45° field of view:
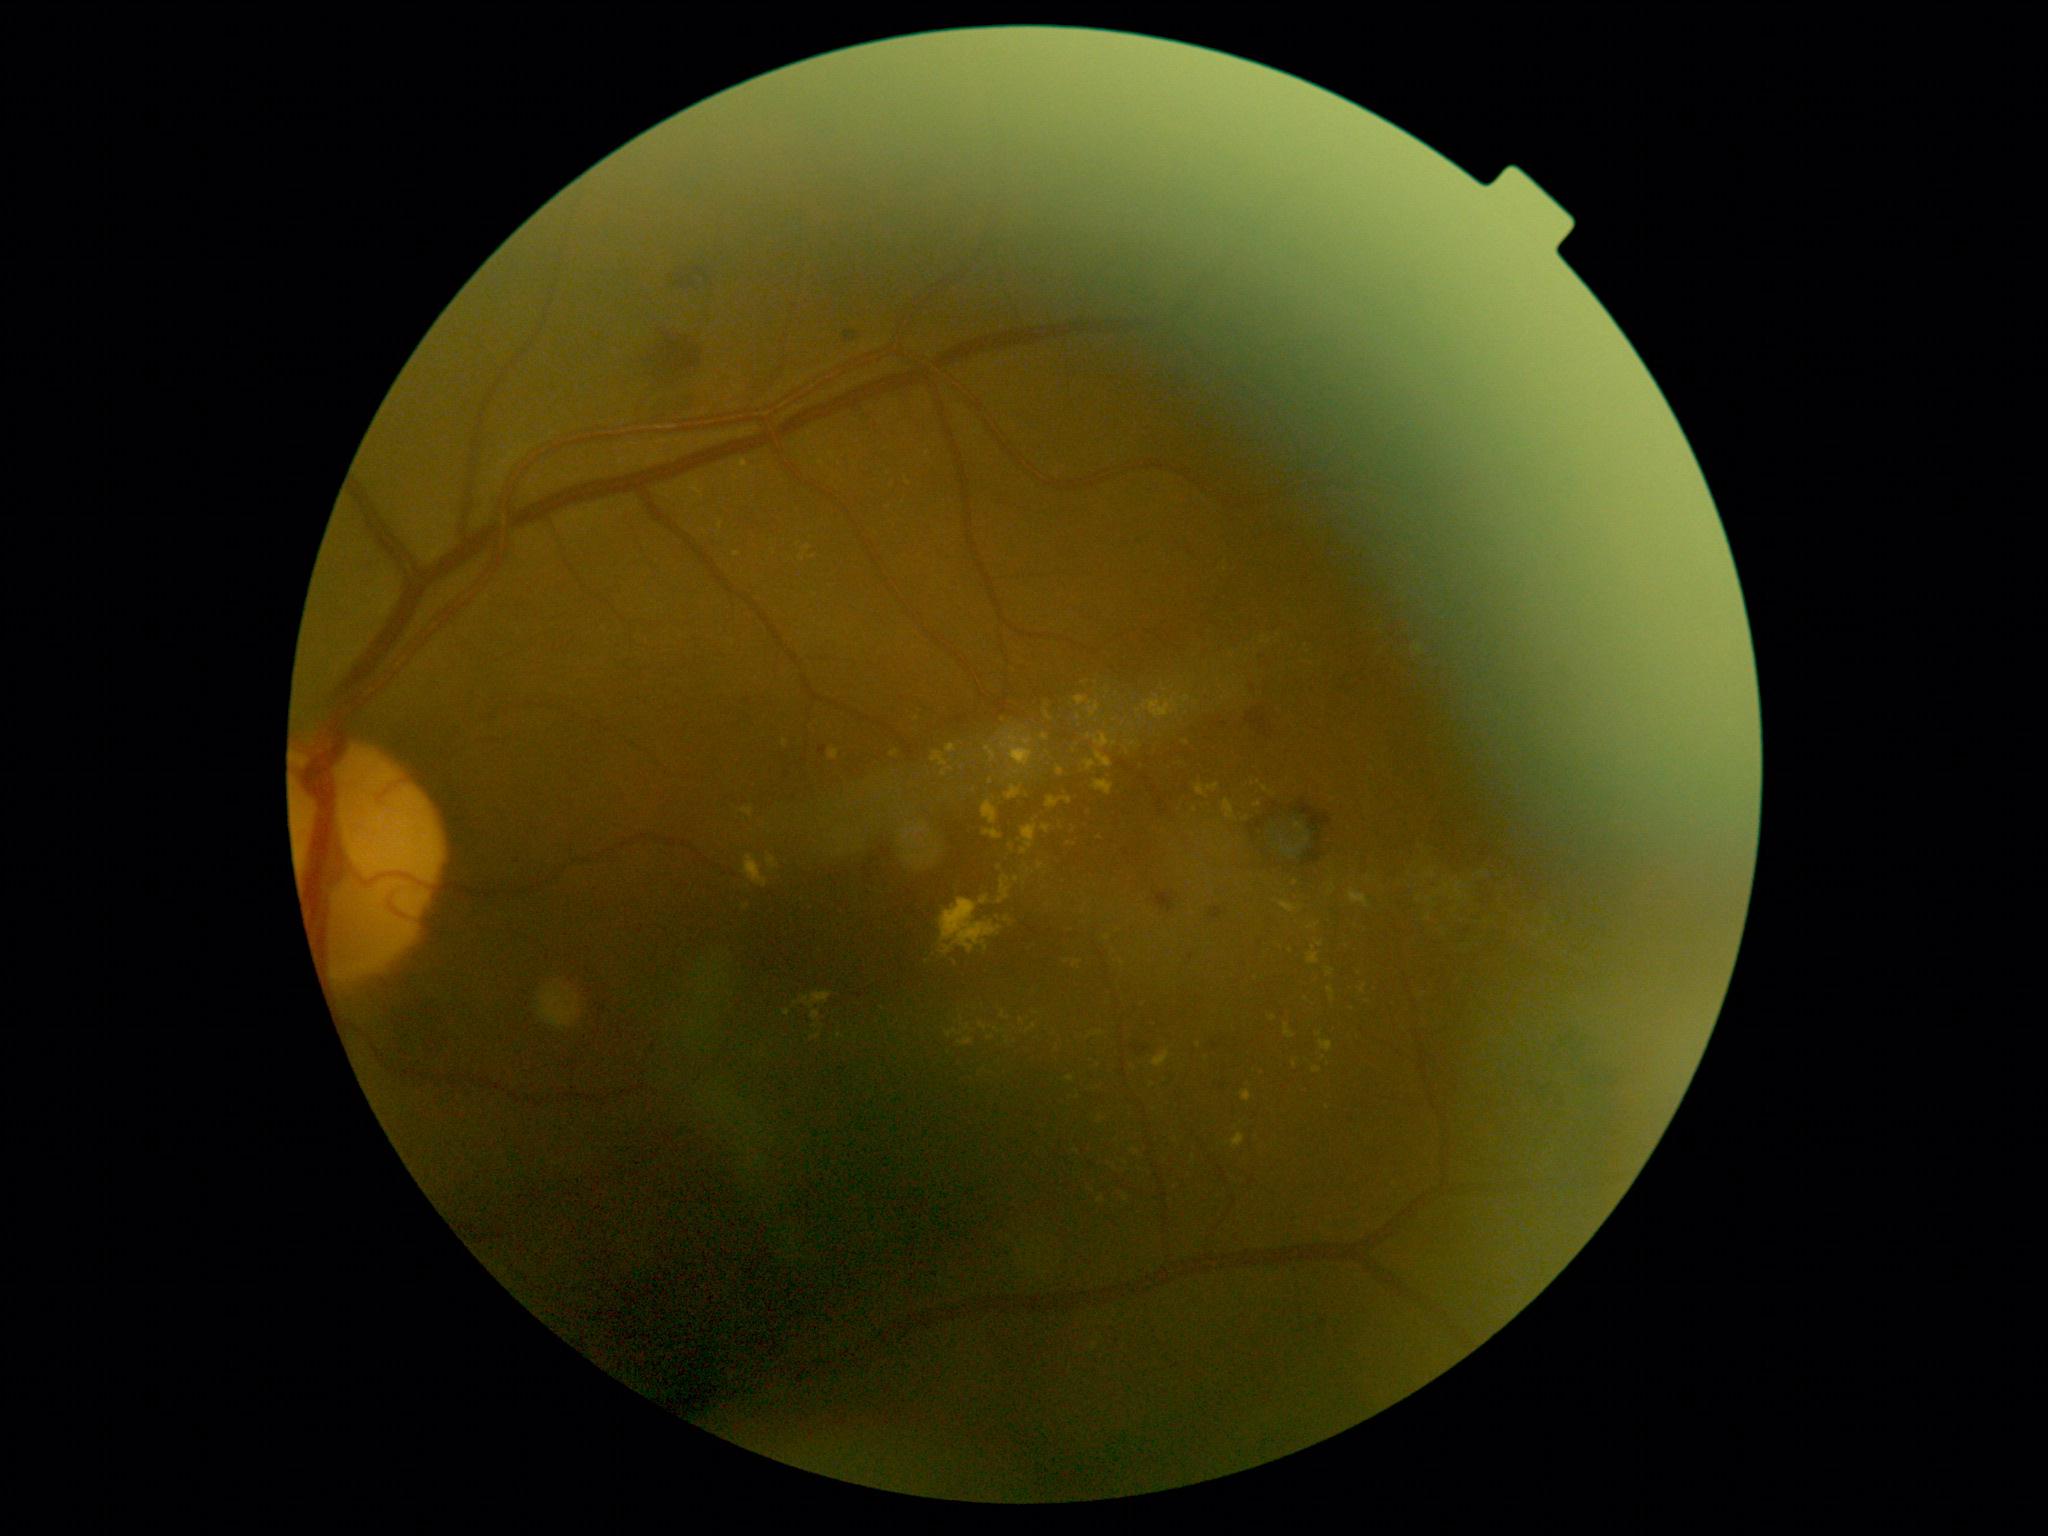
Diabetic retinopathy (DR) is 2.
Hard exudates (EXs) include those at left=830, top=748, right=840, bottom=761 | left=1142, top=695, right=1180, bottom=720 | left=1326, top=968, right=1335, bottom=977 | left=1045, top=710, right=1053, bottom=722 | left=1349, top=890, right=1370, bottom=908 | left=931, top=752, right=948, bottom=767 | left=945, top=1030, right=964, bottom=1039 | left=1041, top=735, right=1050, bottom=742.
Additional small EXs near [1000,868] | [944,774] | [802,558] | [1307,999] | [813,557] | [1314,948] | [1016,879] | [1022,1022] | [1069,844] | [1199,1045].